Camera: NIDEK AFC-230, 45-degree field of view, nonmydriatic, 848x848px, color fundus photograph — 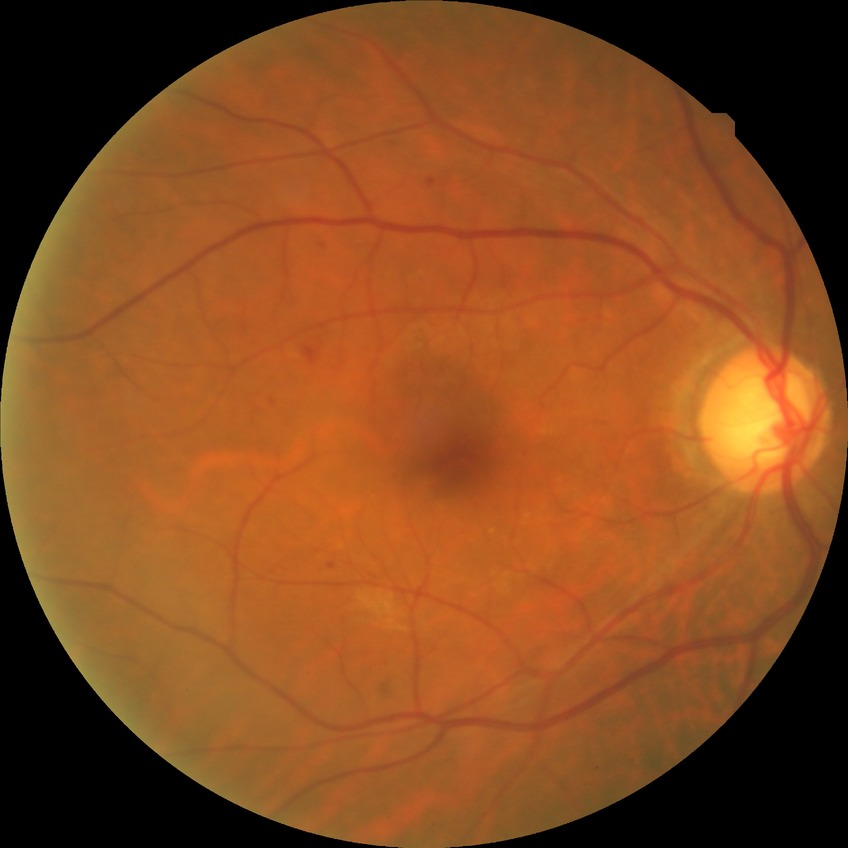 Assessment:
- diabetic retinopathy (DR) — pre-proliferative diabetic retinopathy (PPDR)